Retinal fundus photograph · 45° field of view — 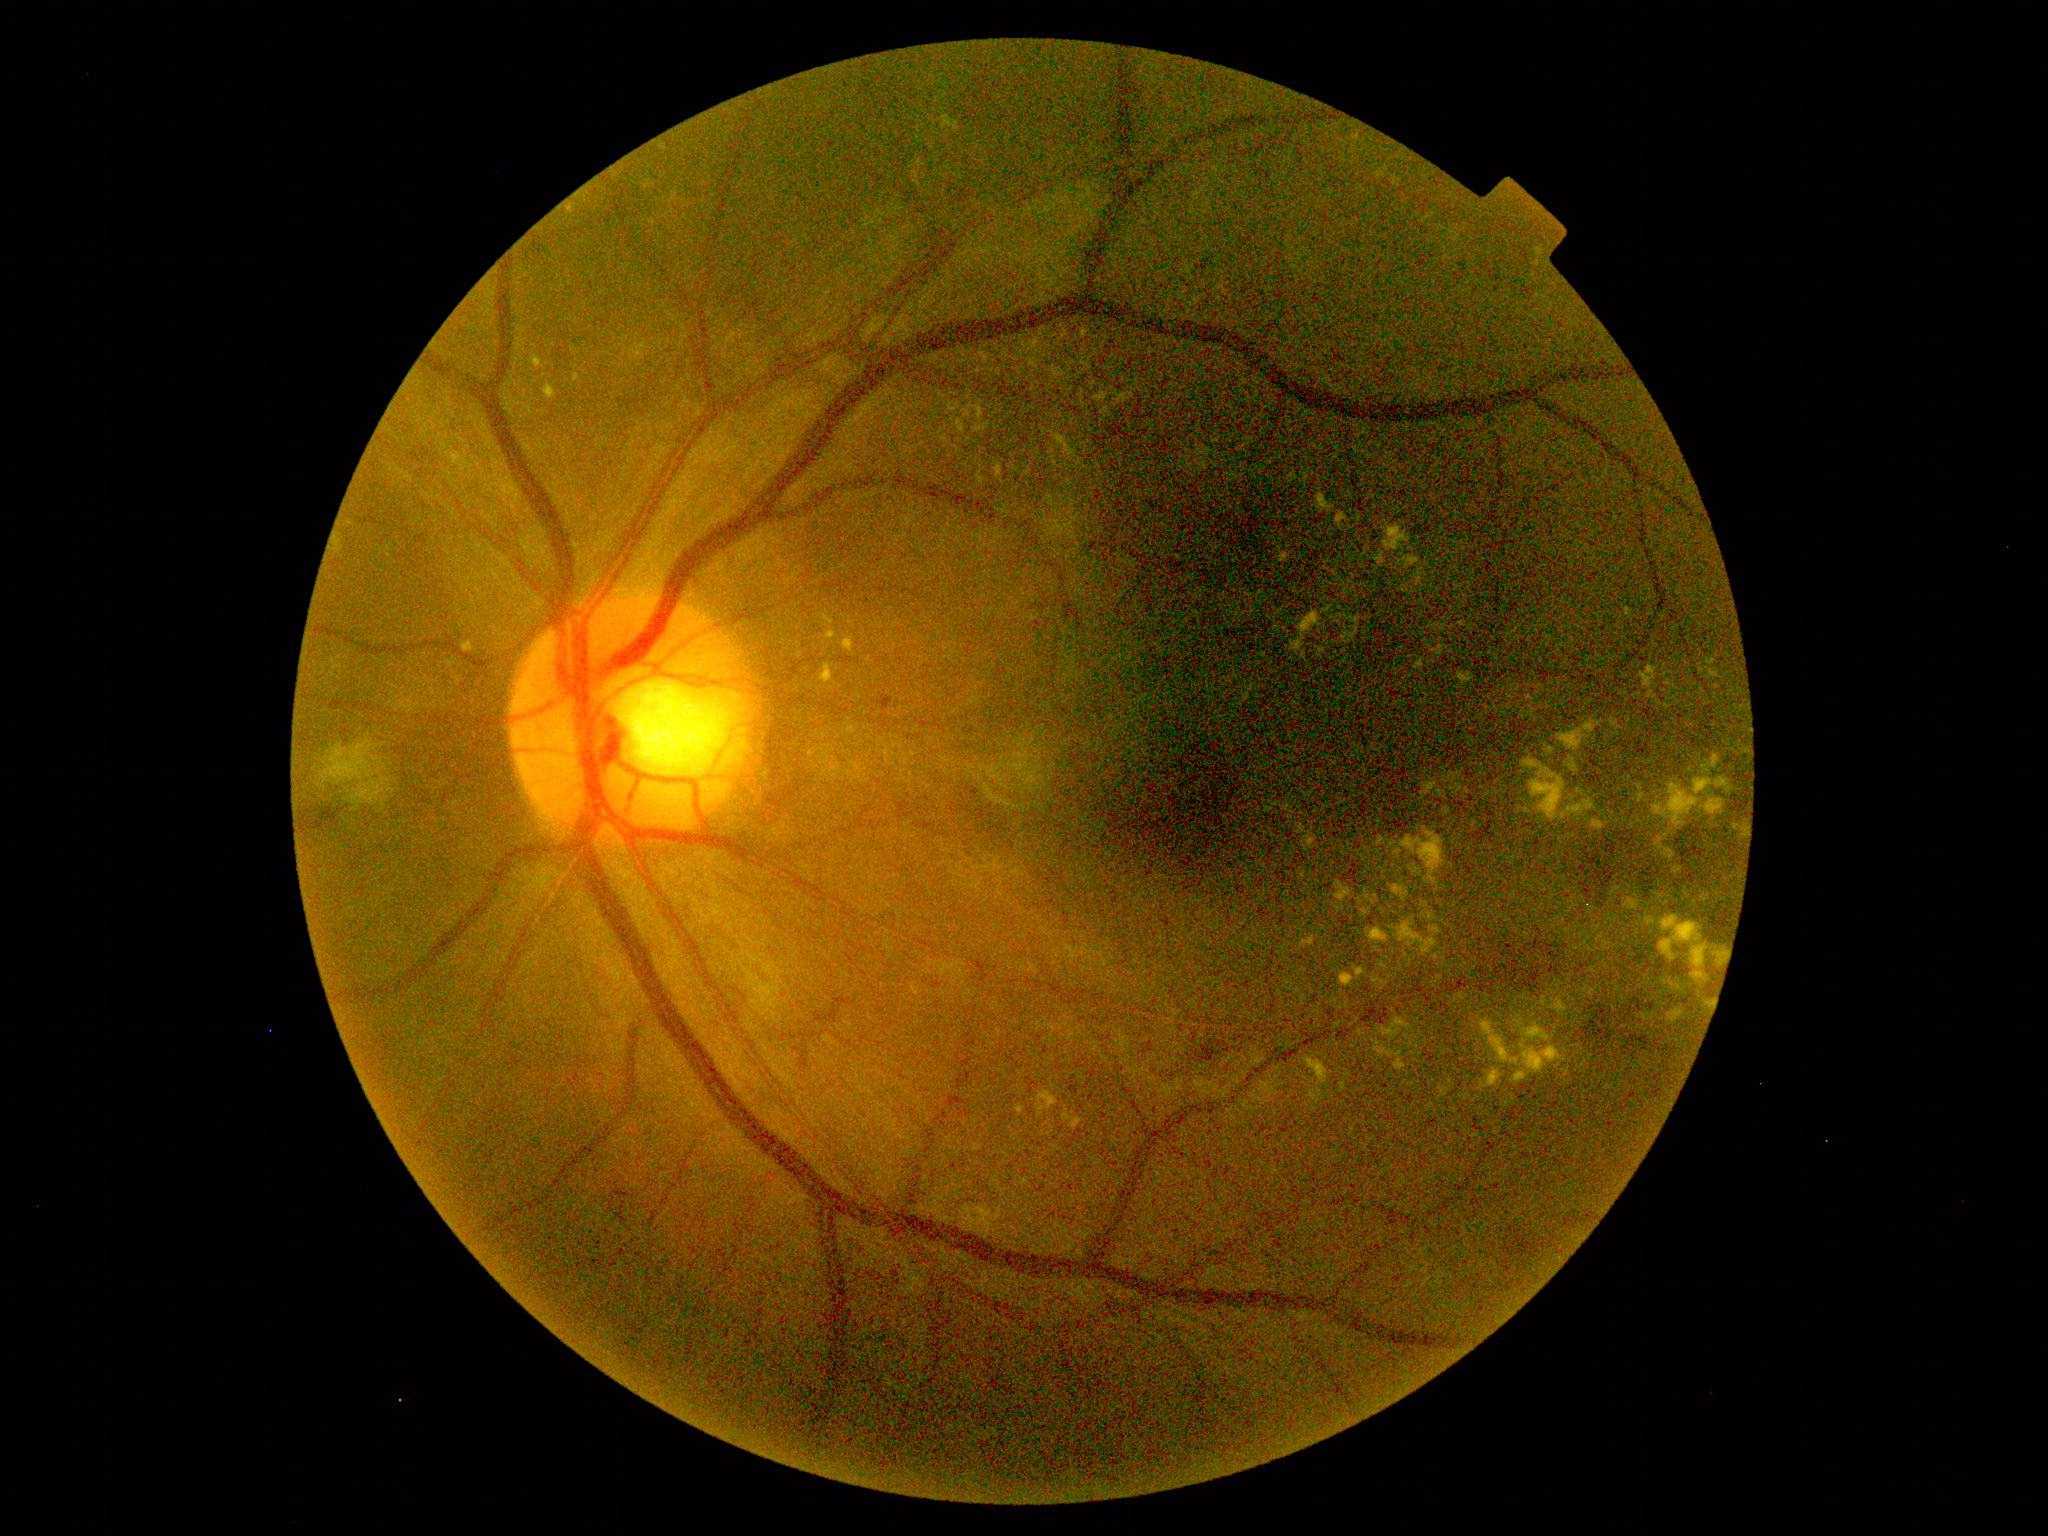 Diabetic retinopathy (DR): moderate NPDR (grade 2).